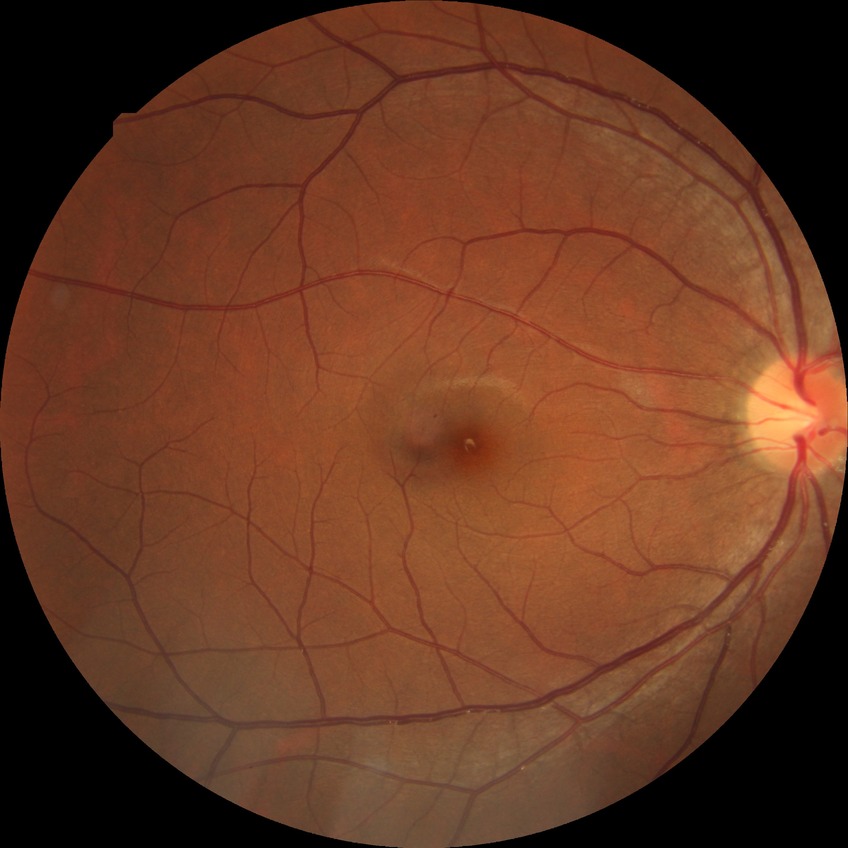
diabetic retinopathy (DR): NDR (no diabetic retinopathy).